Wide-field fundus photograph from neonatal ROP screening. Camera: Clarity RetCam 3 (130° FOV).
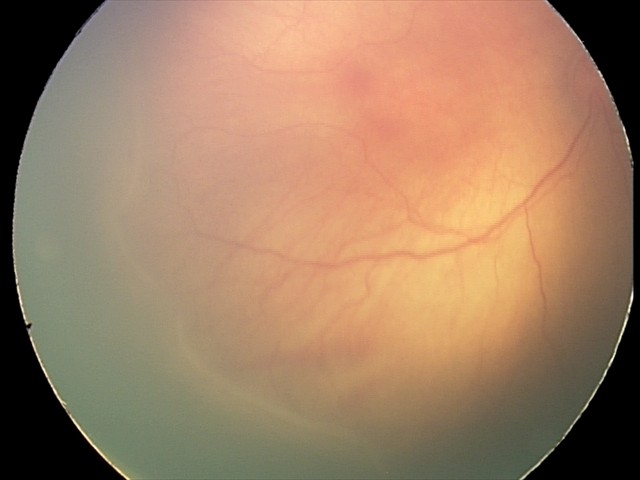 Assessment: no plus disease | retinopathy of prematurity (ROP) stage 2.